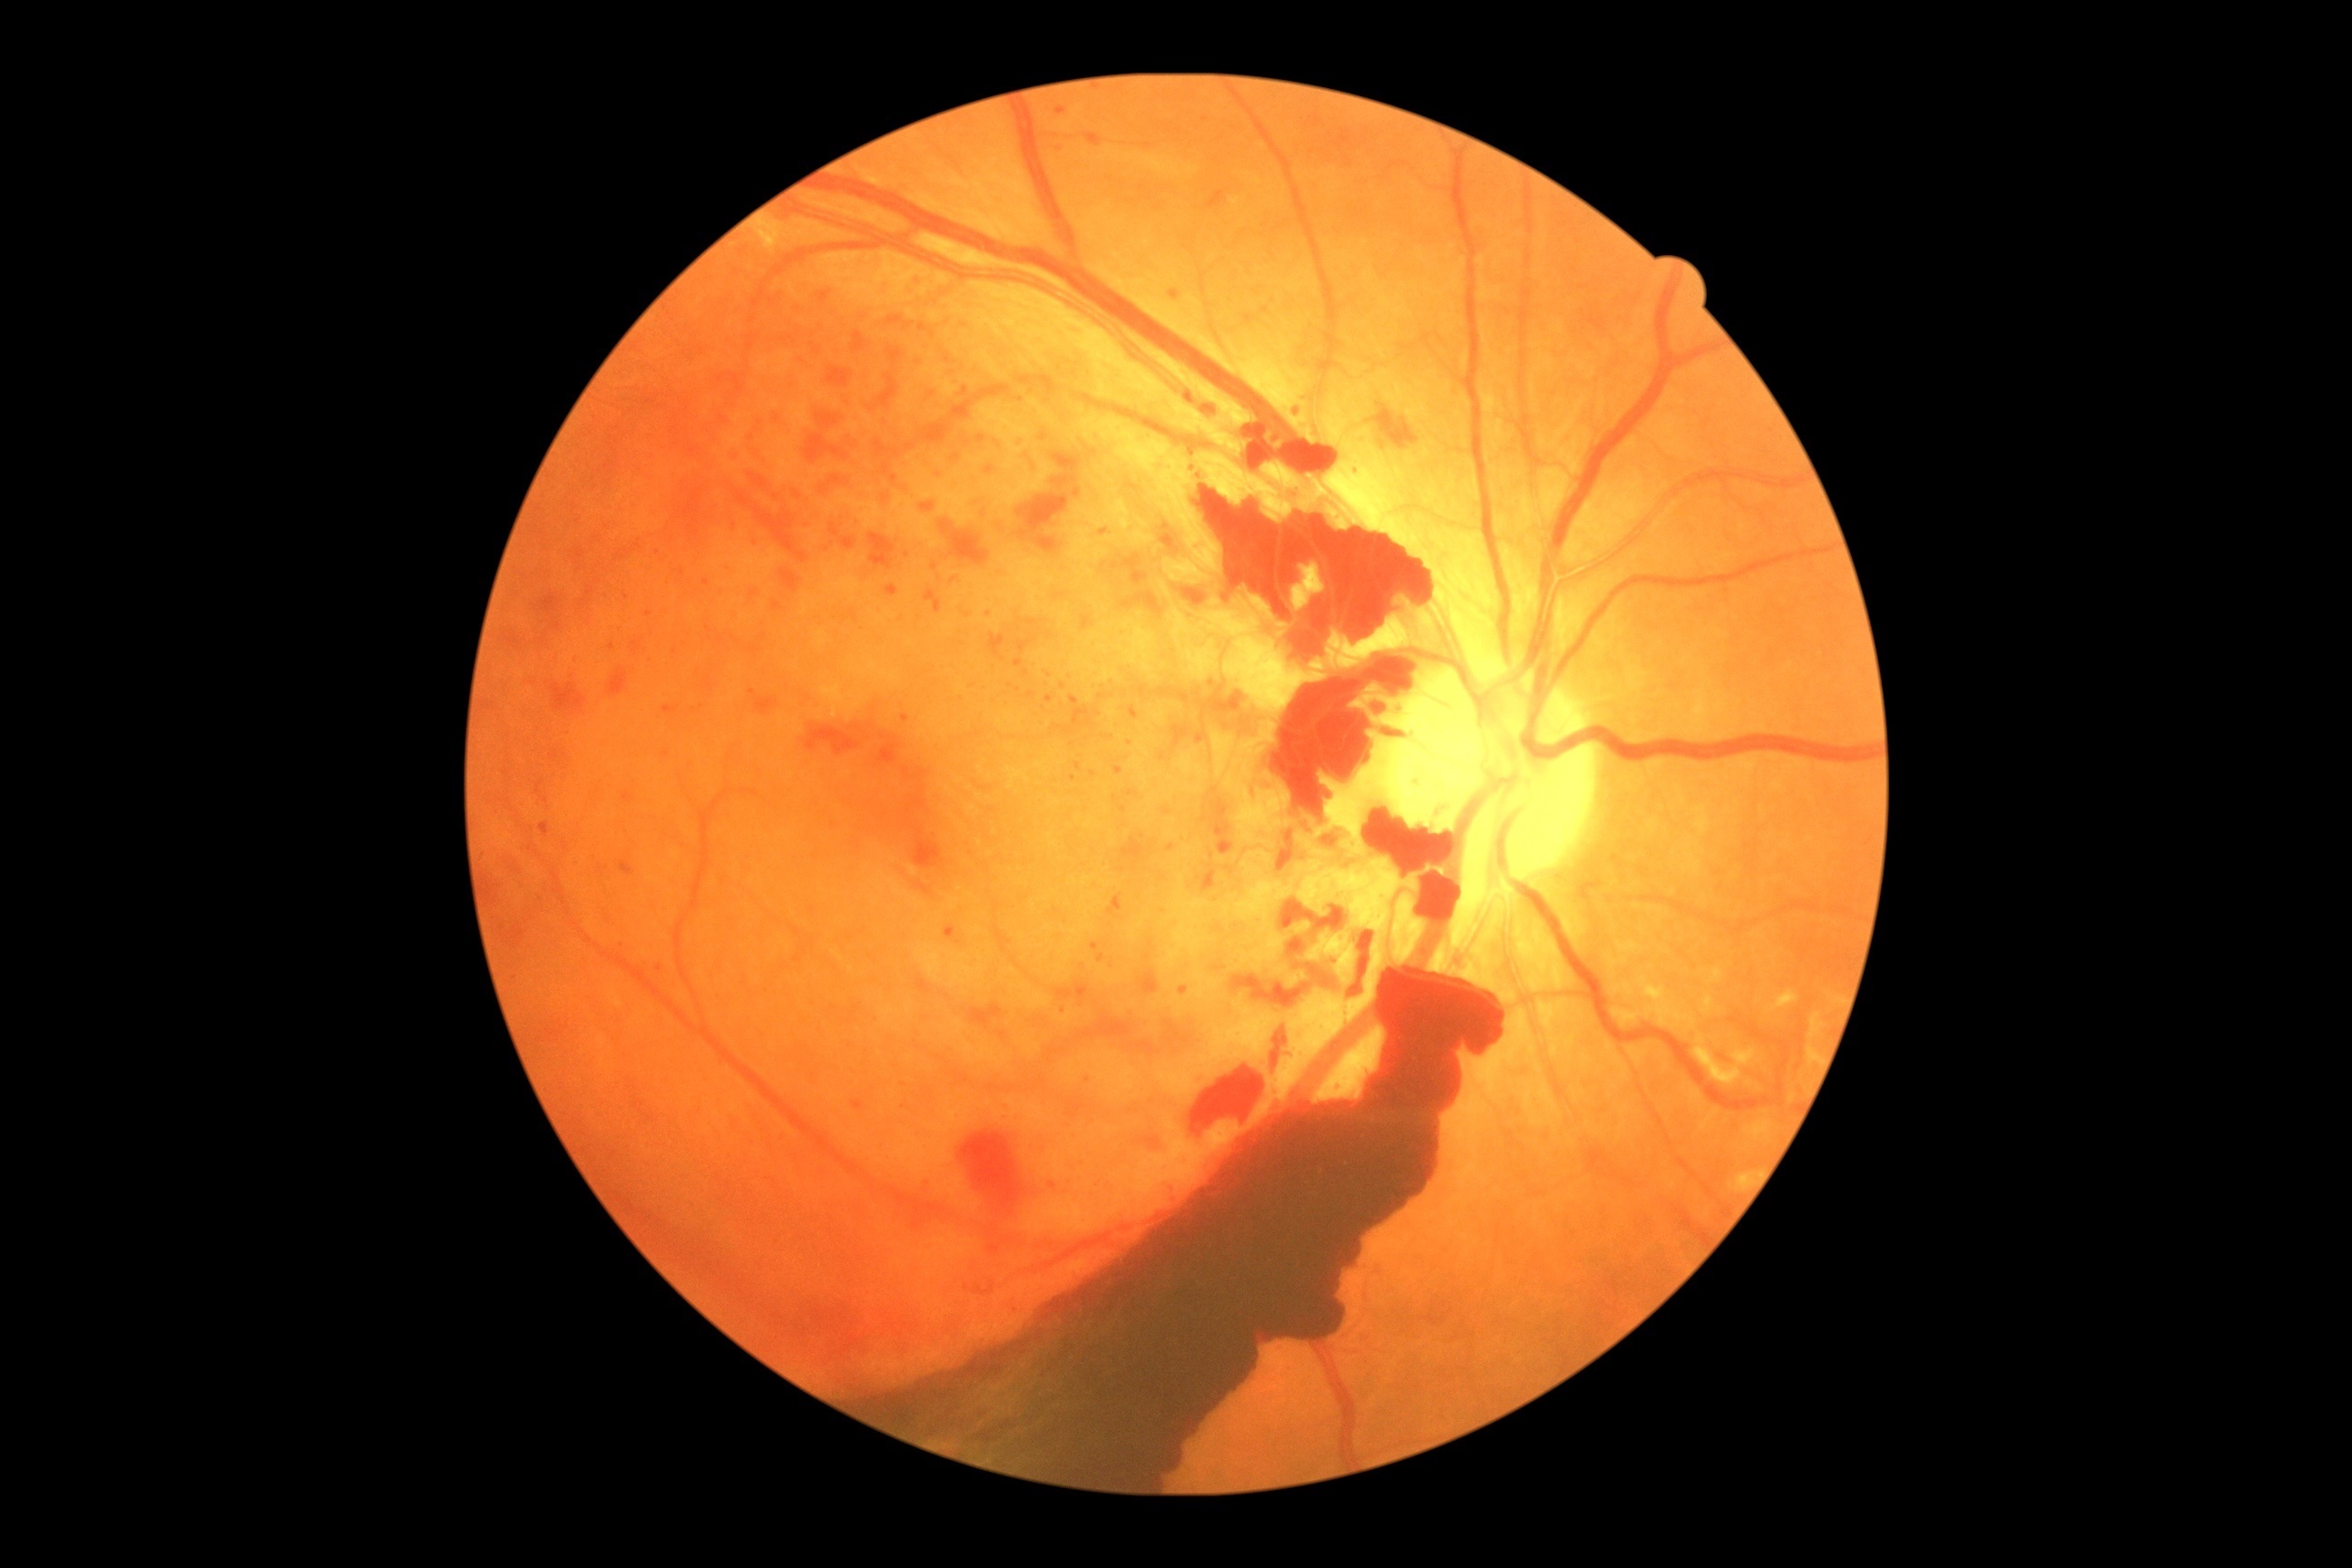 DR grade = 4.